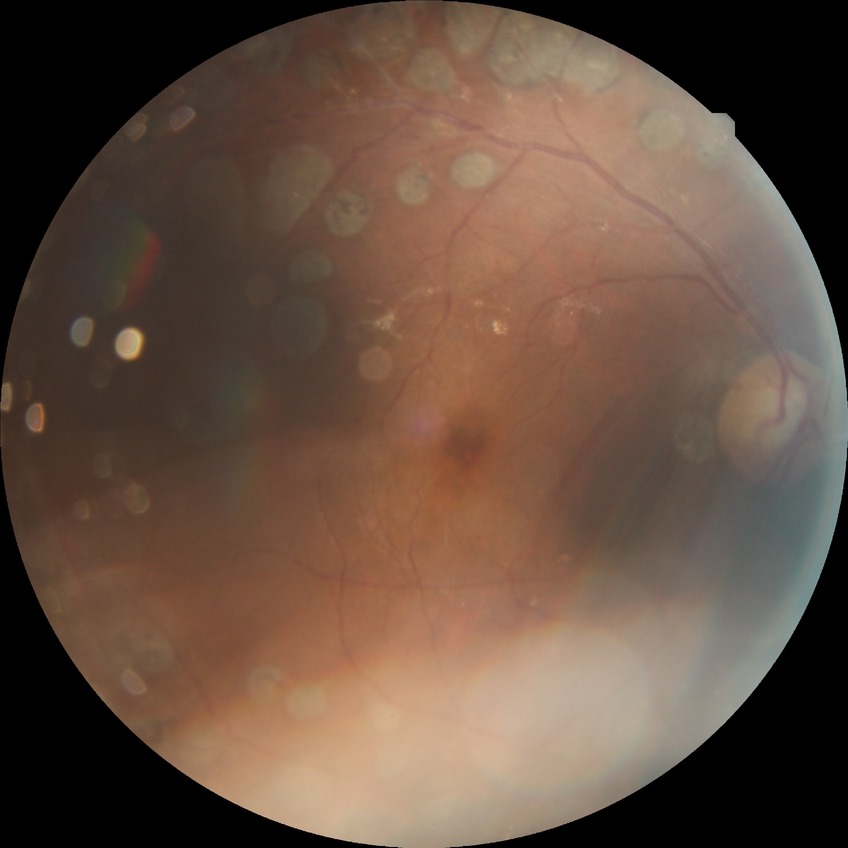 diabetic retinopathy severity: proliferative diabetic retinopathy